Wide-field fundus photograph of an infant. Camera: Clarity RetCam 3 (130° FOV). 640 by 480 pixels — 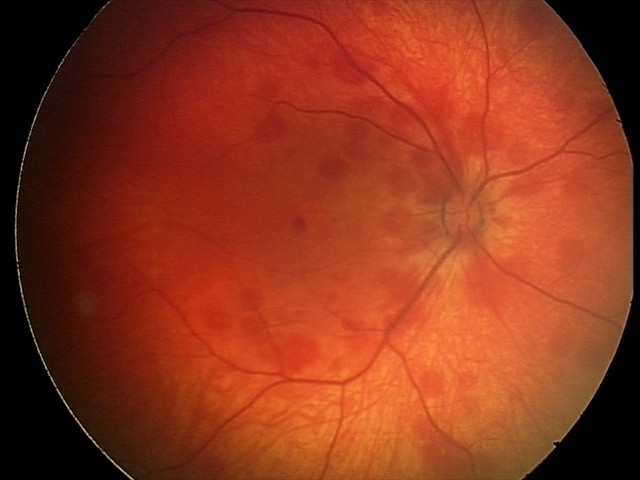
Diagnosis from this screening exam: retinal hemorrhages.